Nonmydriatic.
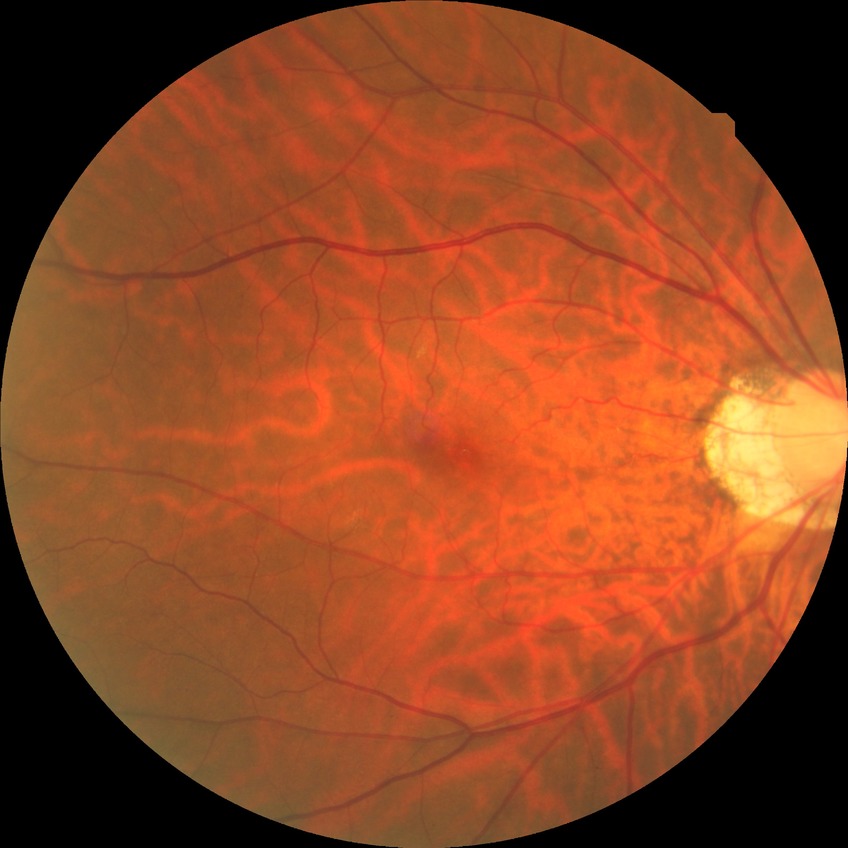 Davis grading: no diabetic retinopathy.